Color fundus photograph — 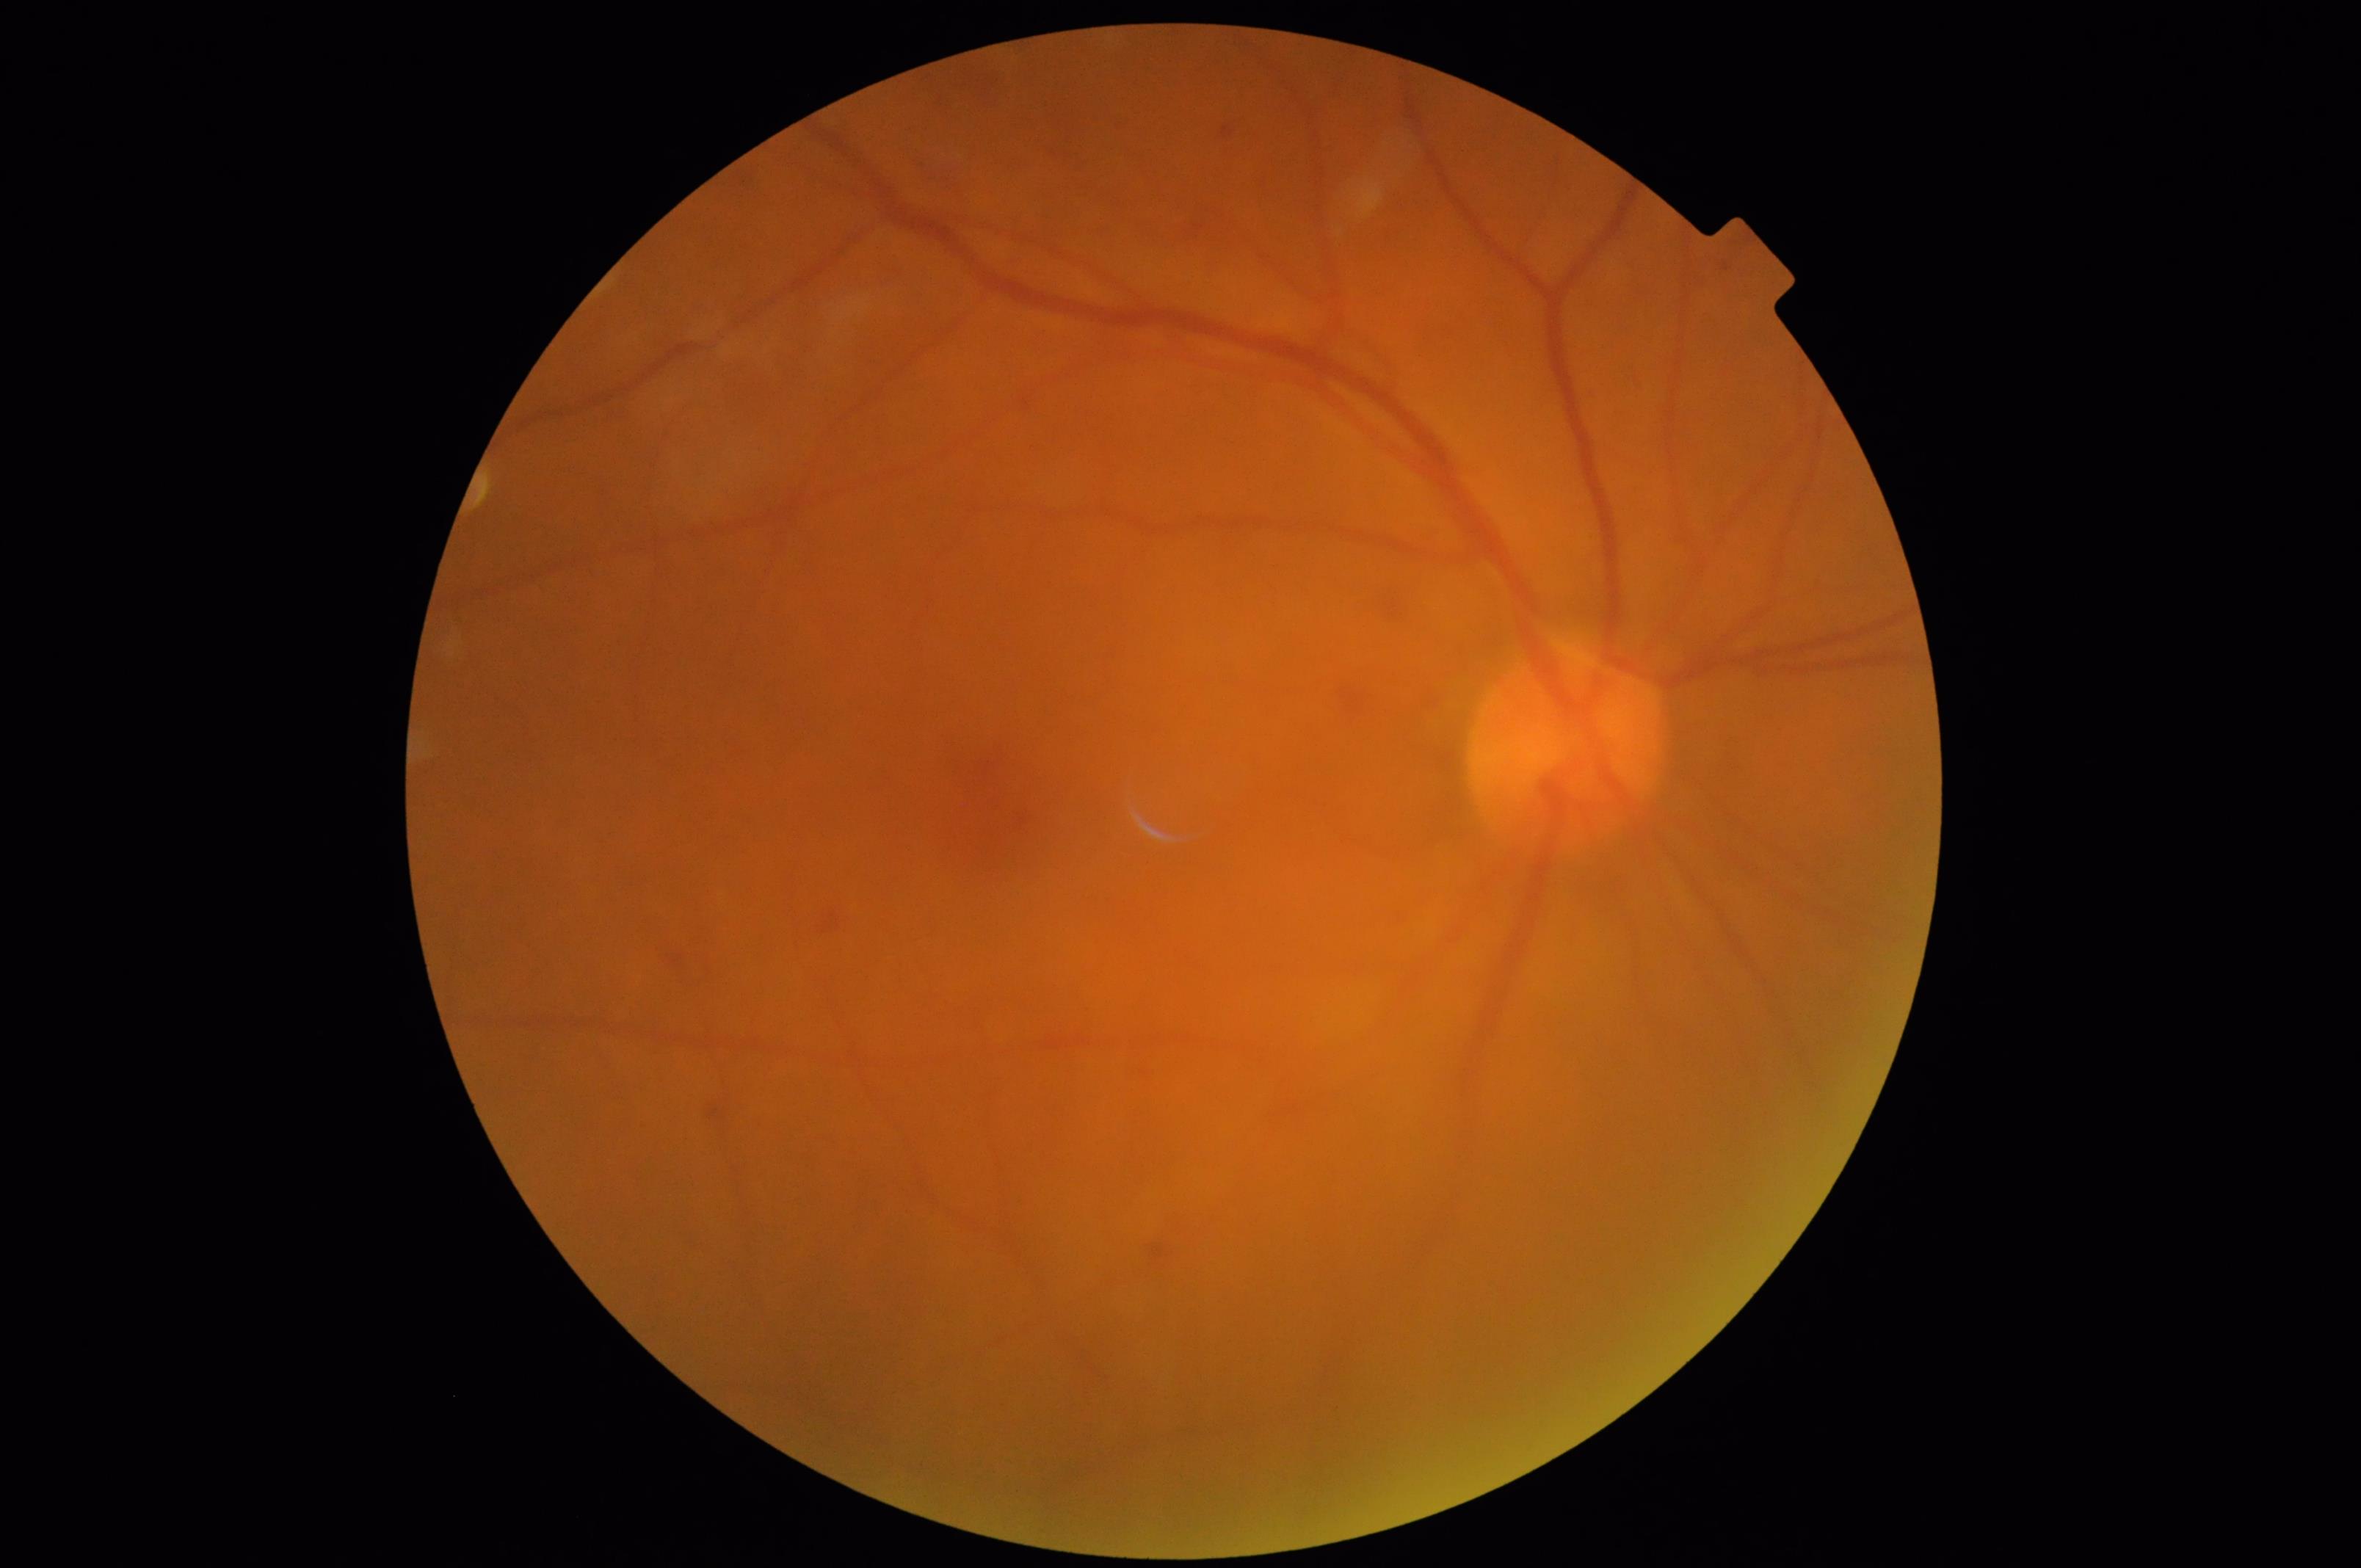 Image quality is suboptimal.
Noticeable blur in the optic disc, vessels, or background.
Contrast is good.
Even illumination with no color cast.